Without pupil dilation · 45° FOV — 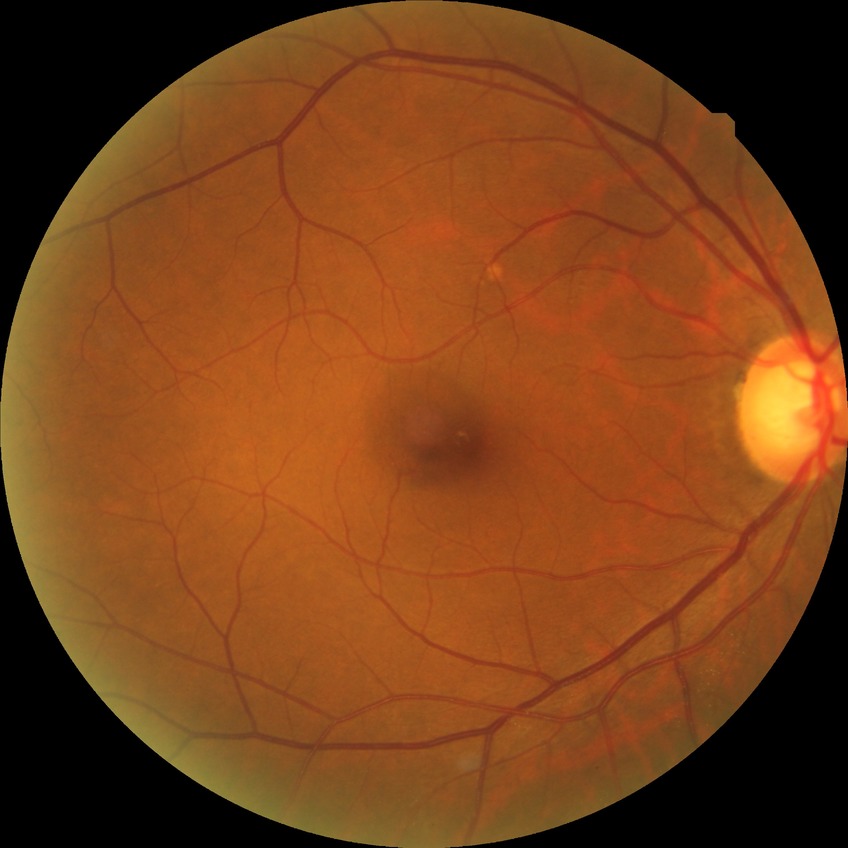

{
  "davis_grade": "no diabetic retinopathy"
}